DR severity per modified Davis staging
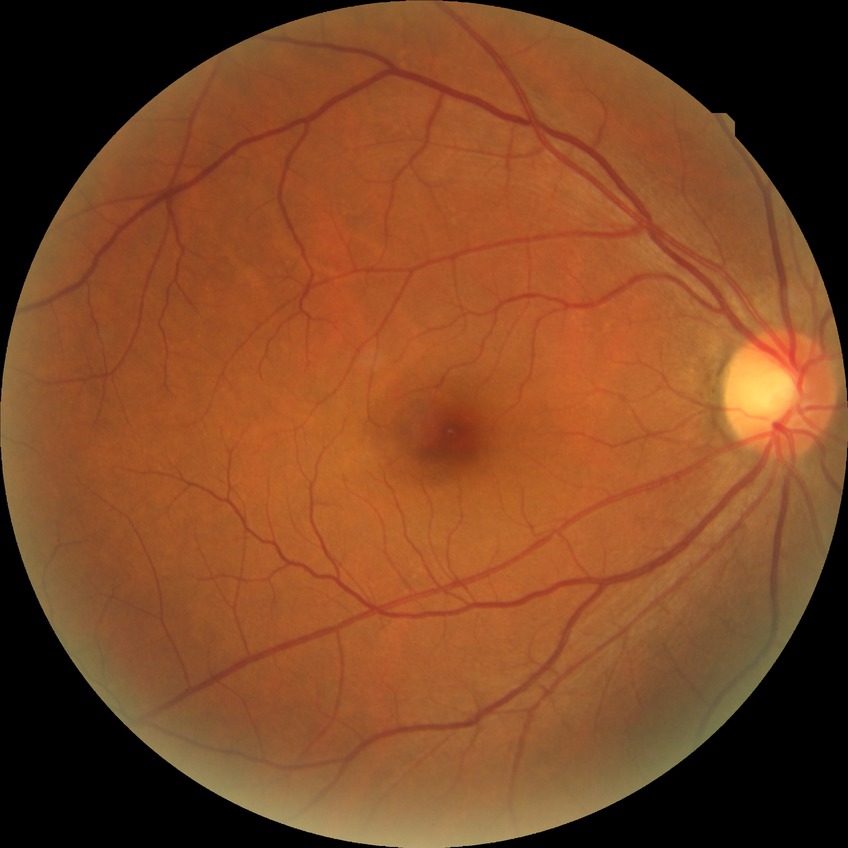

Retinopathy grade: no diabetic retinopathy.